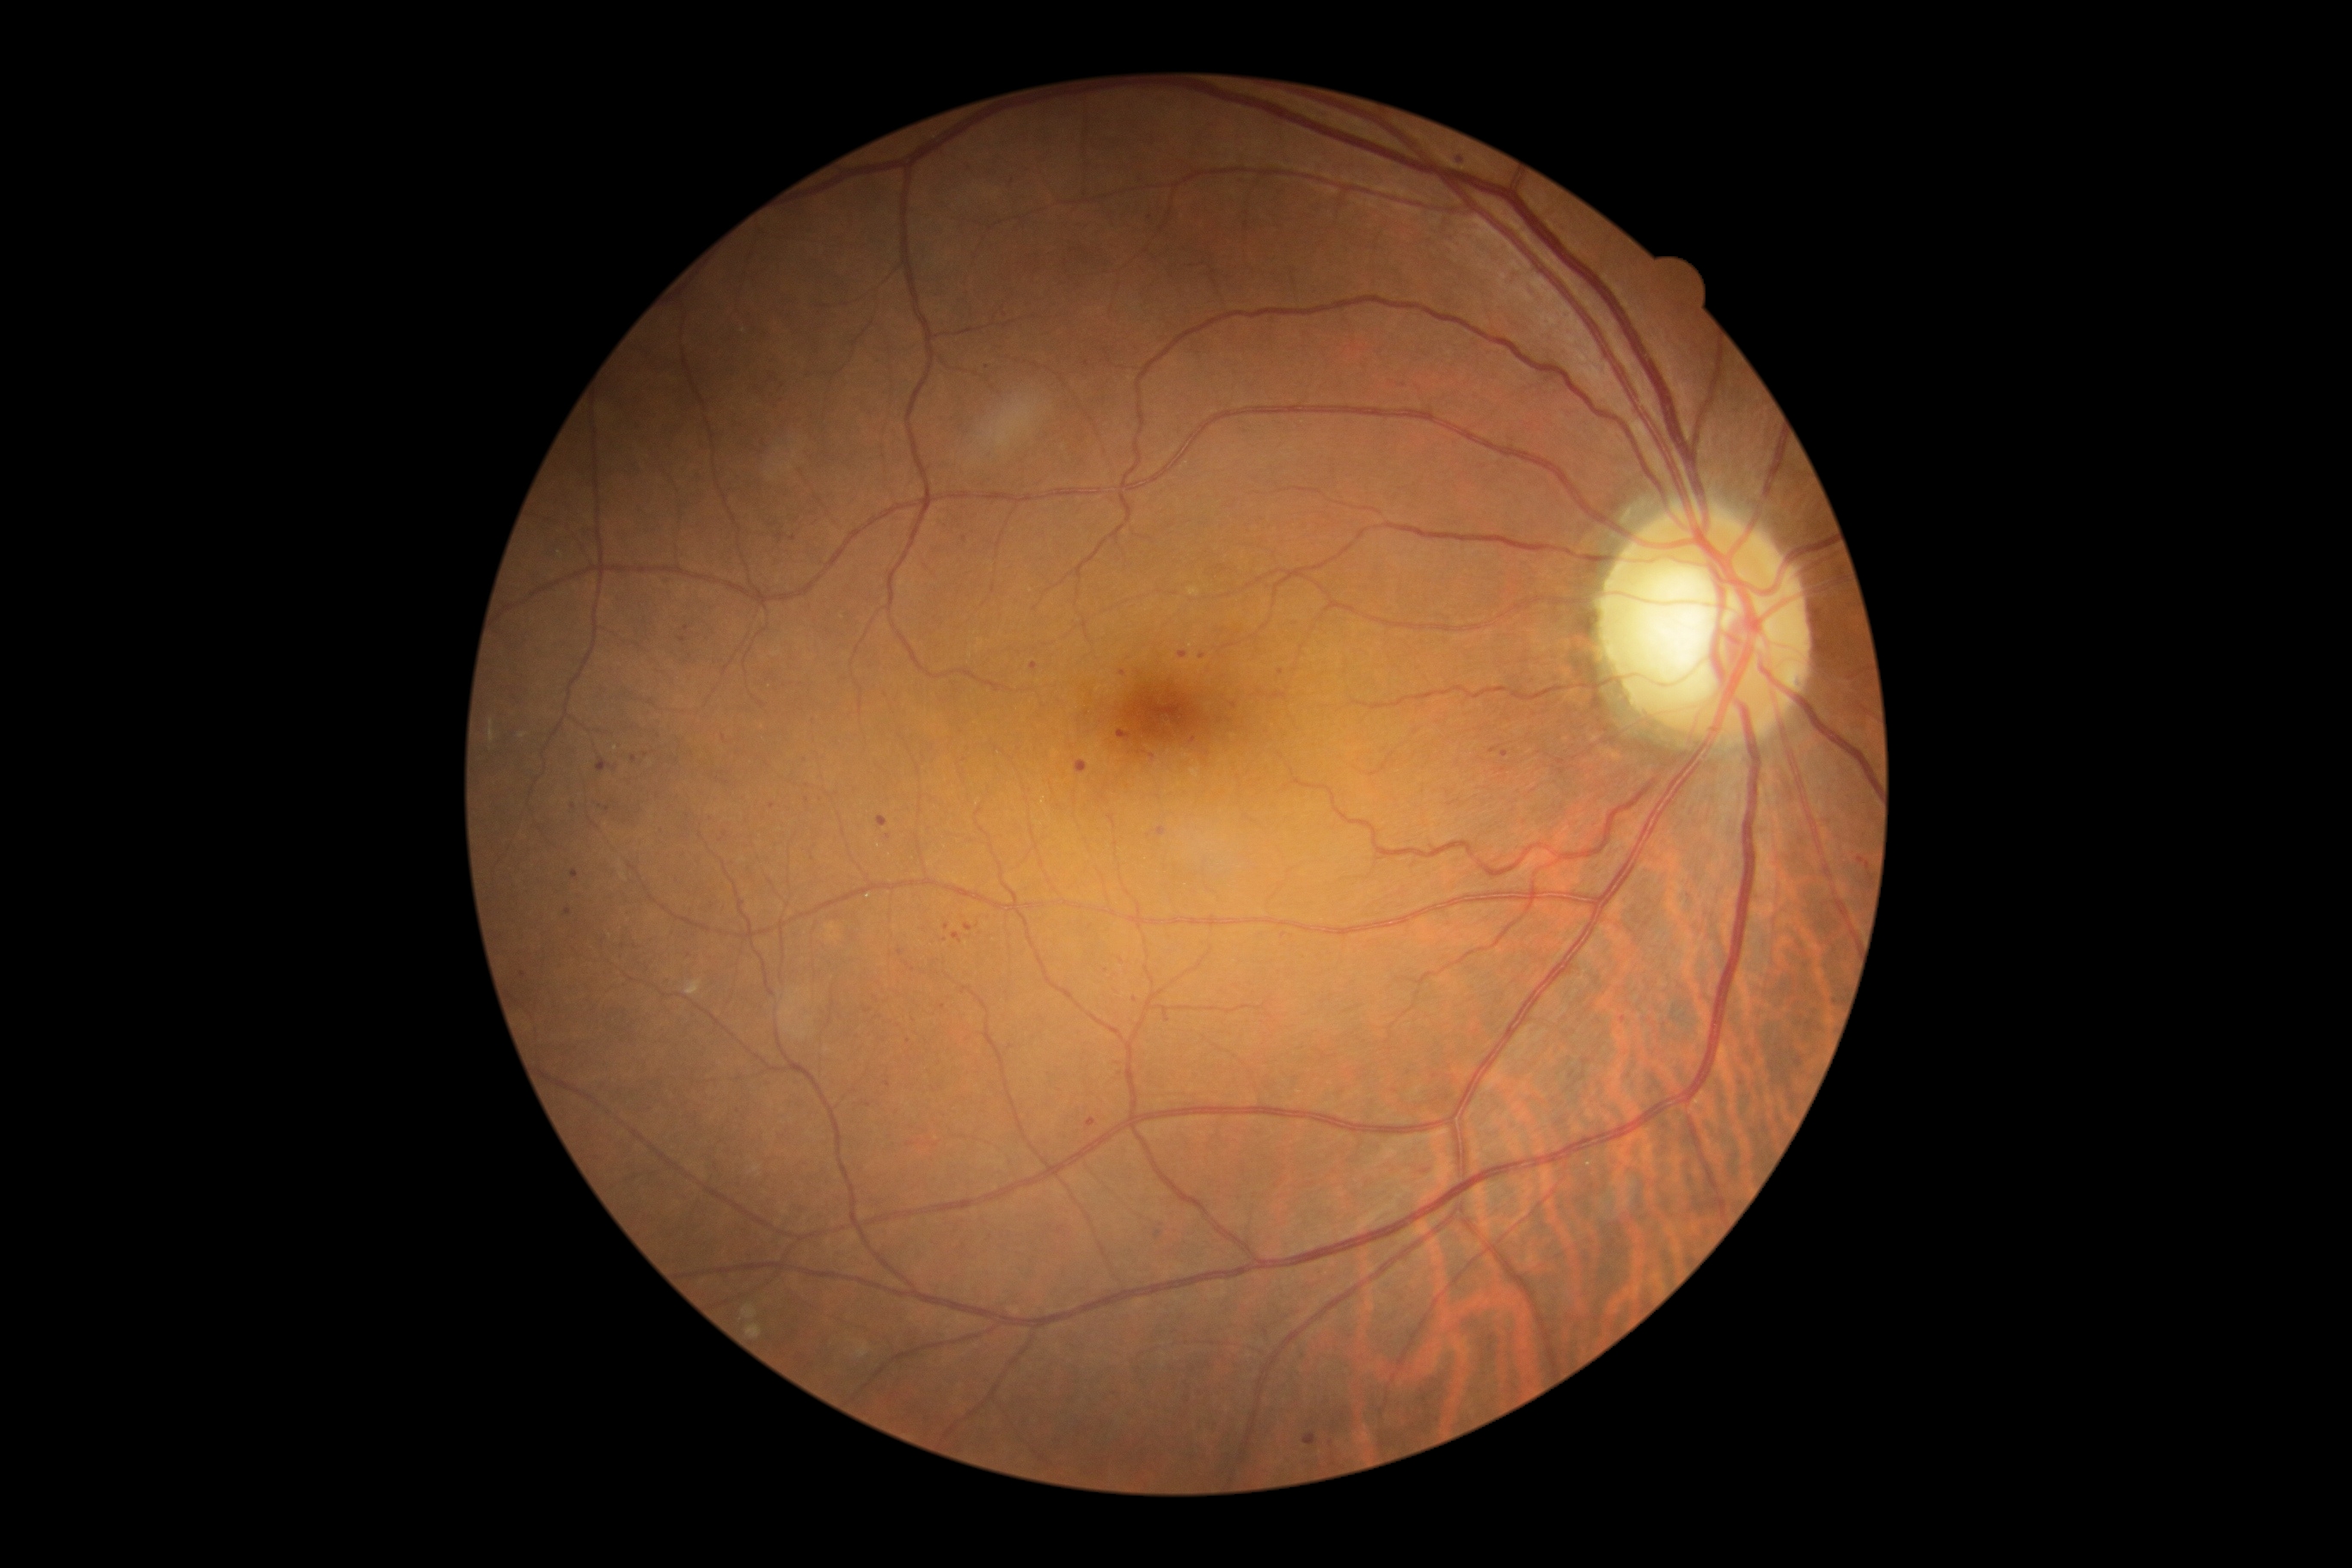

Diabetic retinopathy (DR) is mild non-proliferative diabetic retinopathy (grade 1)
A subset of detected lesions:
microaneurysms (MAs) (partial): box(572, 869, 579, 881); box(878, 816, 888, 828); box(1500, 750, 1509, 757); box(965, 924, 972, 933)
Small MAs approximately at (901; 953); (942; 1007); (888; 837); (523; 974); (1135; 1000); (783; 387); (646; 754); (1013; 183); (721; 840); (1202; 656); (1284; 935); (1868; 862); (1153; 757)